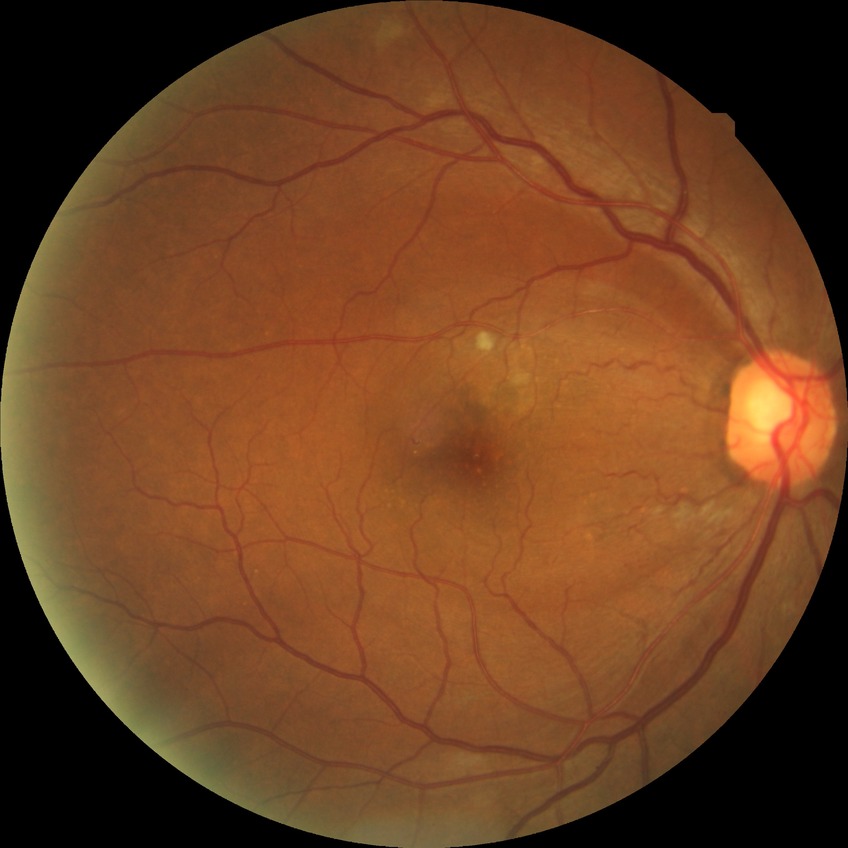 Diabetic retinopathy (DR) is PPDR (pre-proliferative diabetic retinopathy).